Wide-field contact fundus photograph of an infant. Acquired on the Phoenix ICON: 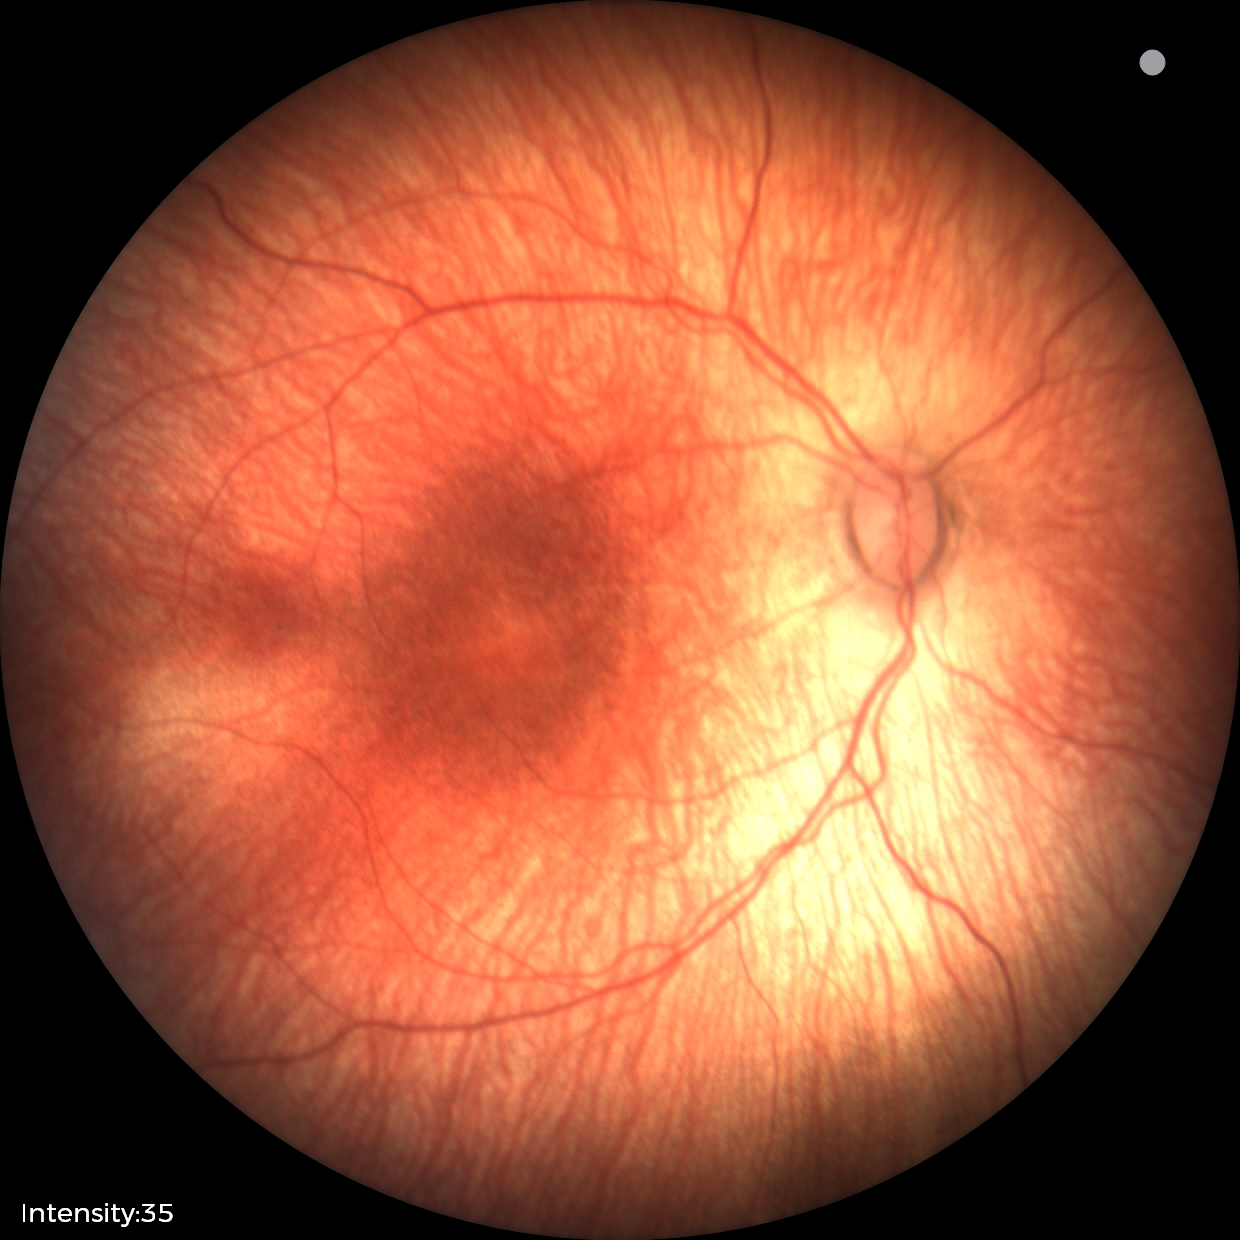

Impression: status post retinopathy of prematurity (ROP) | no plus disease.